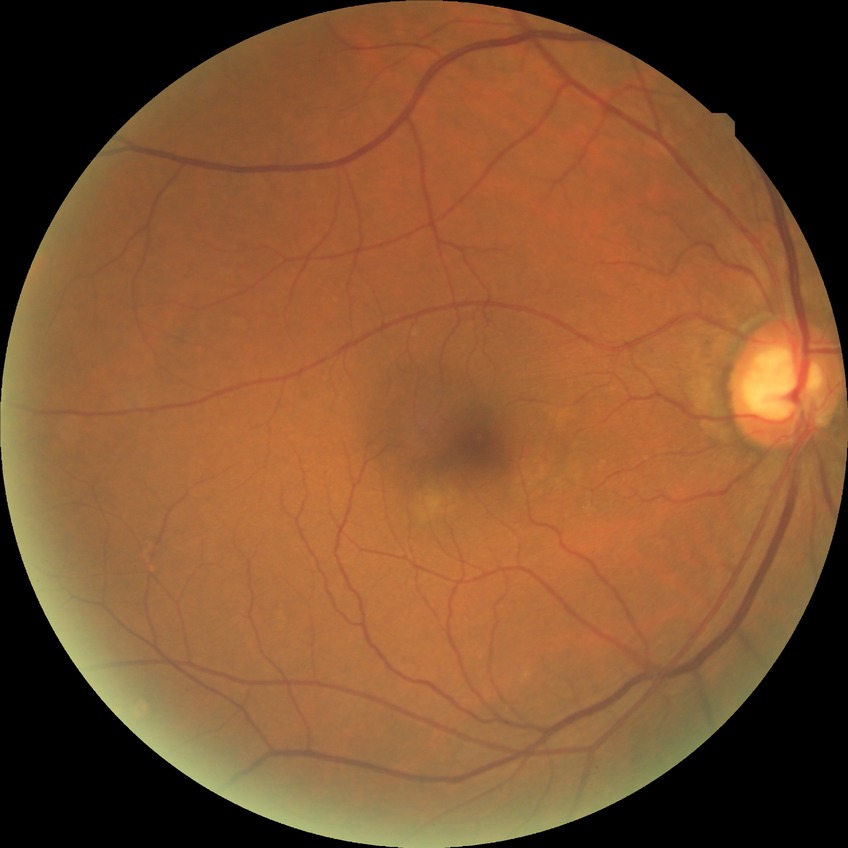
diabetic retinopathy (DR)@NDR (no diabetic retinopathy).